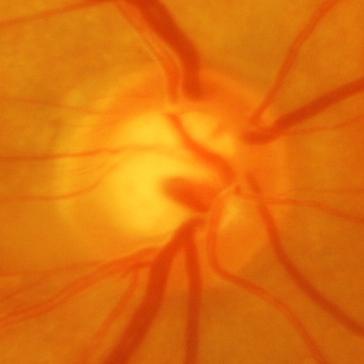
Glaucomatous optic neuropathy is present. The image shows glaucoma.